Wide-field fundus image from infant ROP screening; captured with the Clarity RetCam 3 (130° field of view).
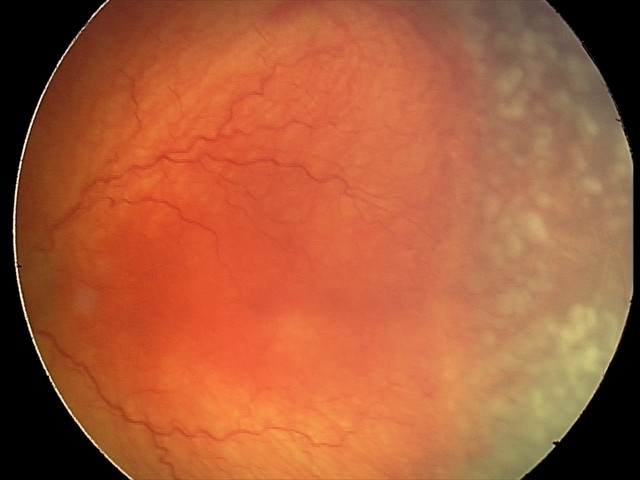 Finding = A-ROP (aggressive ROP)
plus form = present — abnormal dilation and tortuosity of the posterior pole retinal vessels